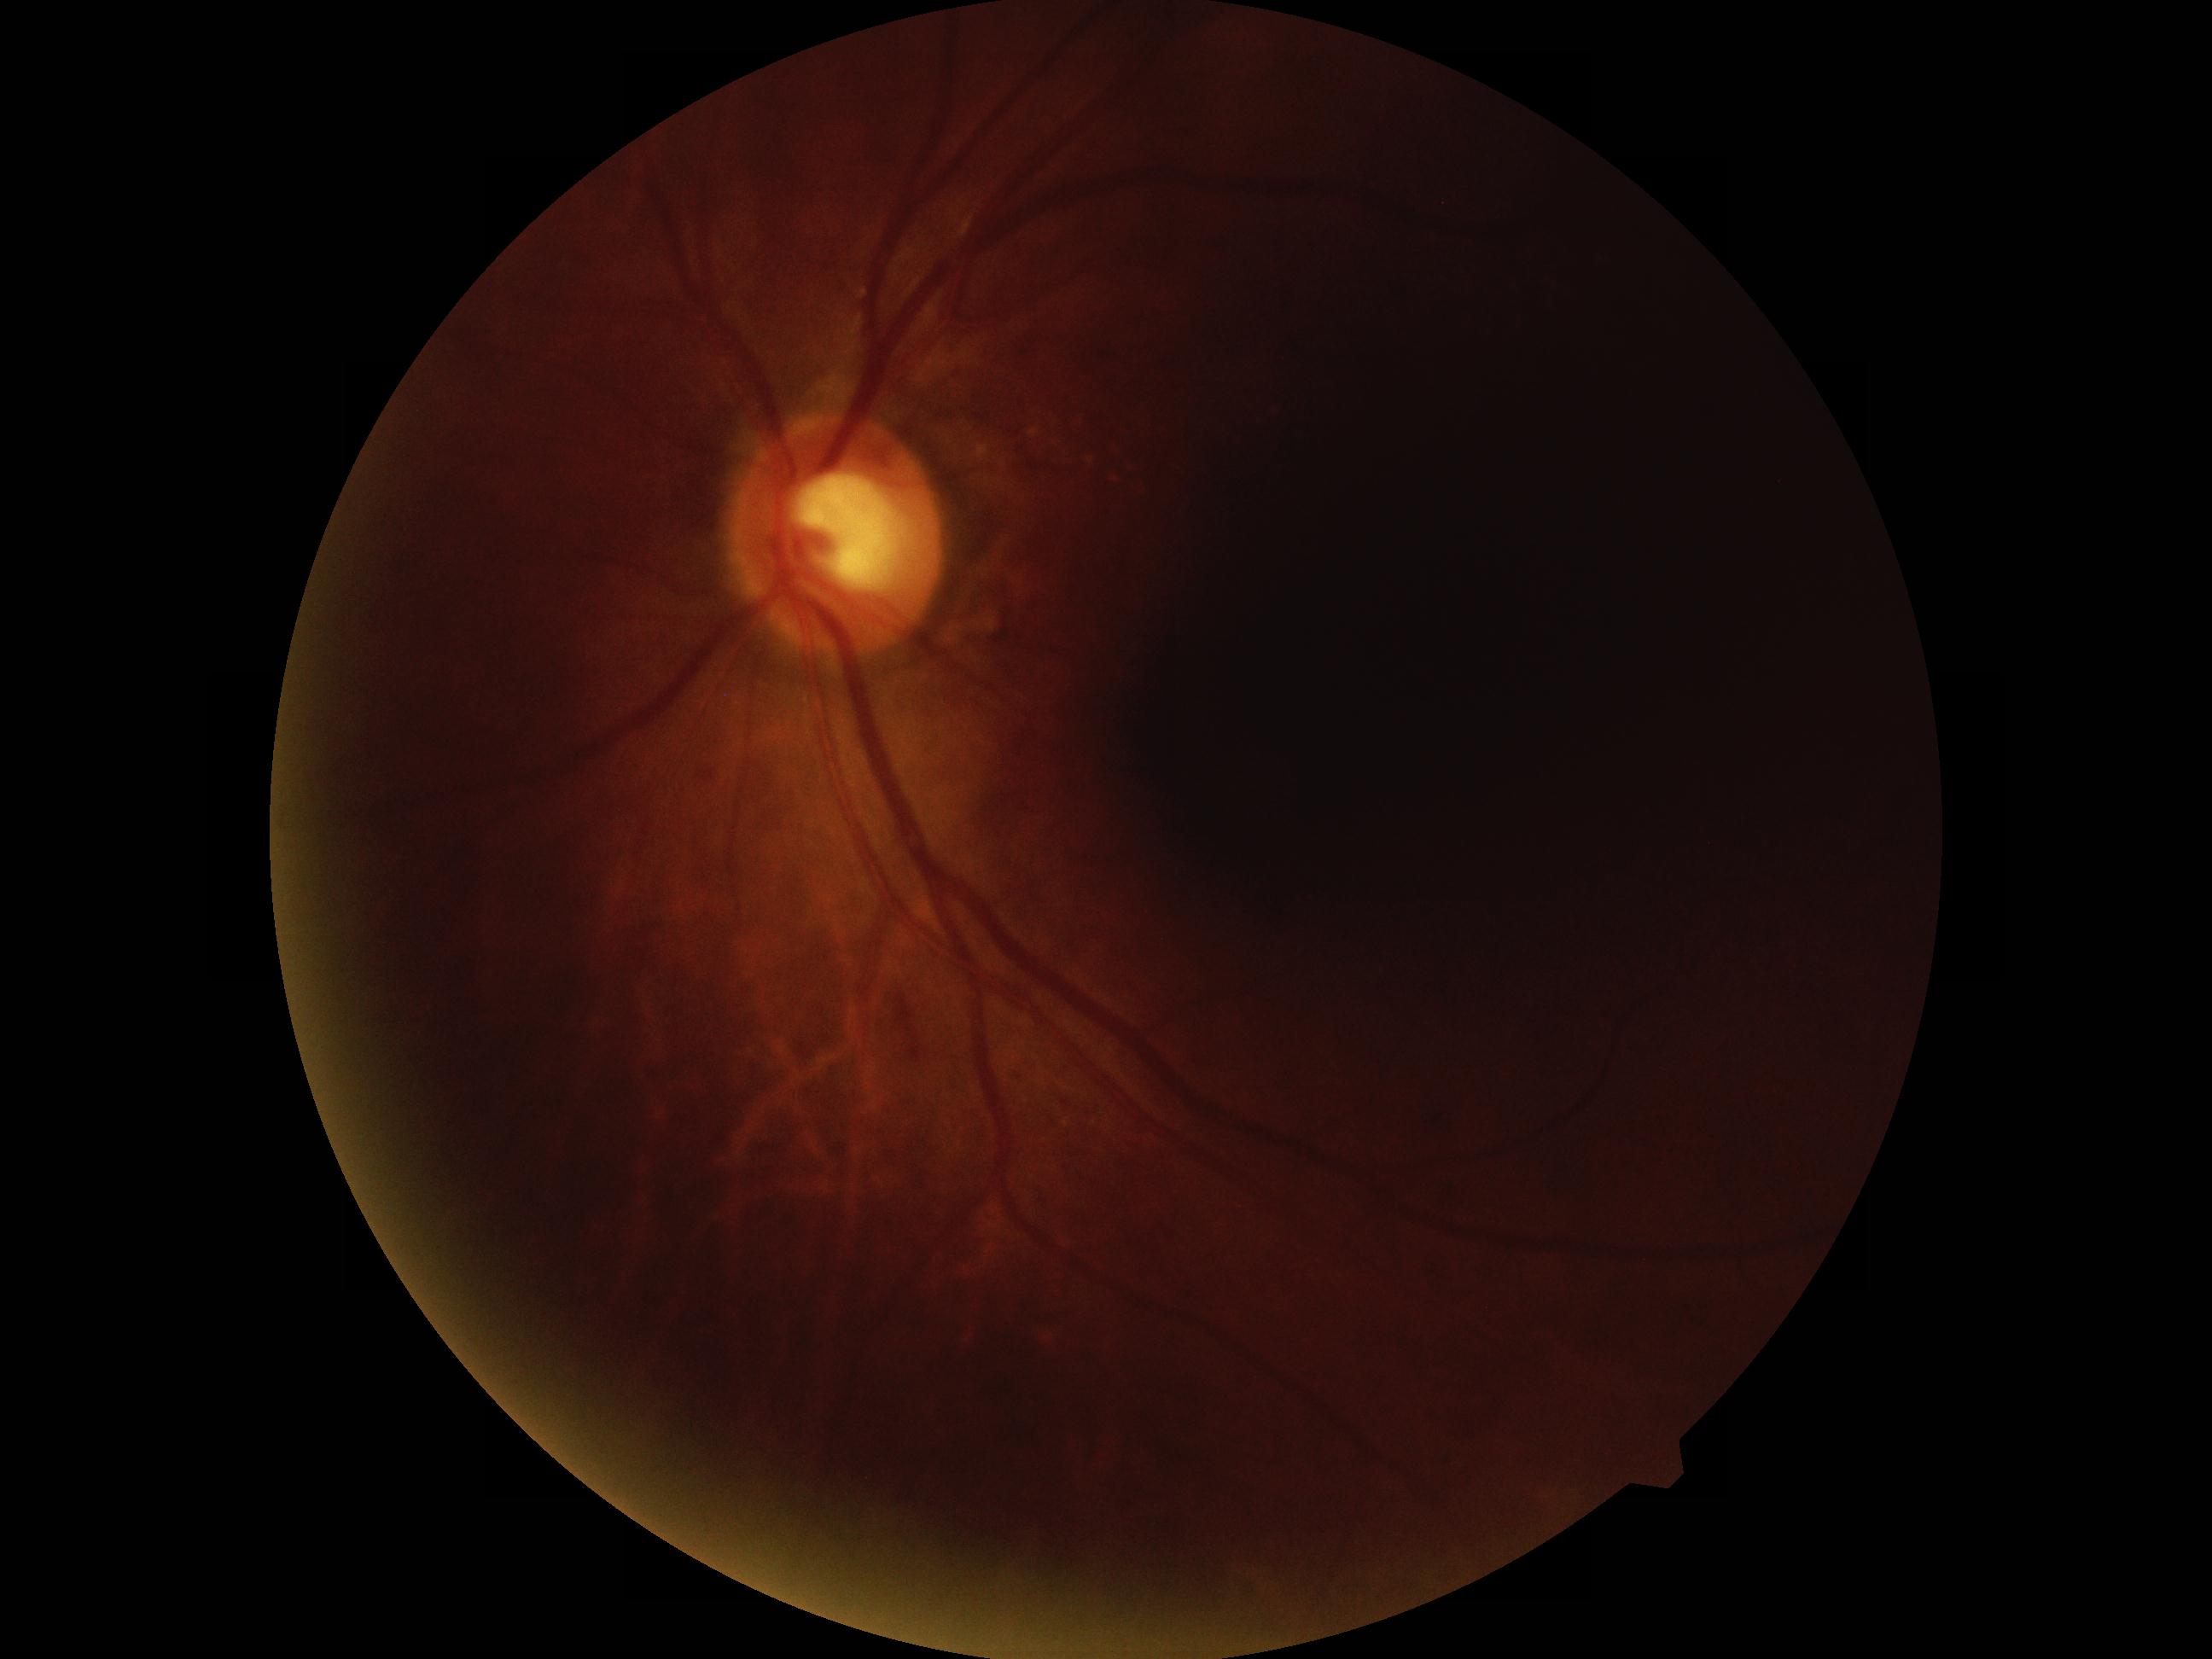 Diabetic retinopathy grade: moderate NPDR (2).